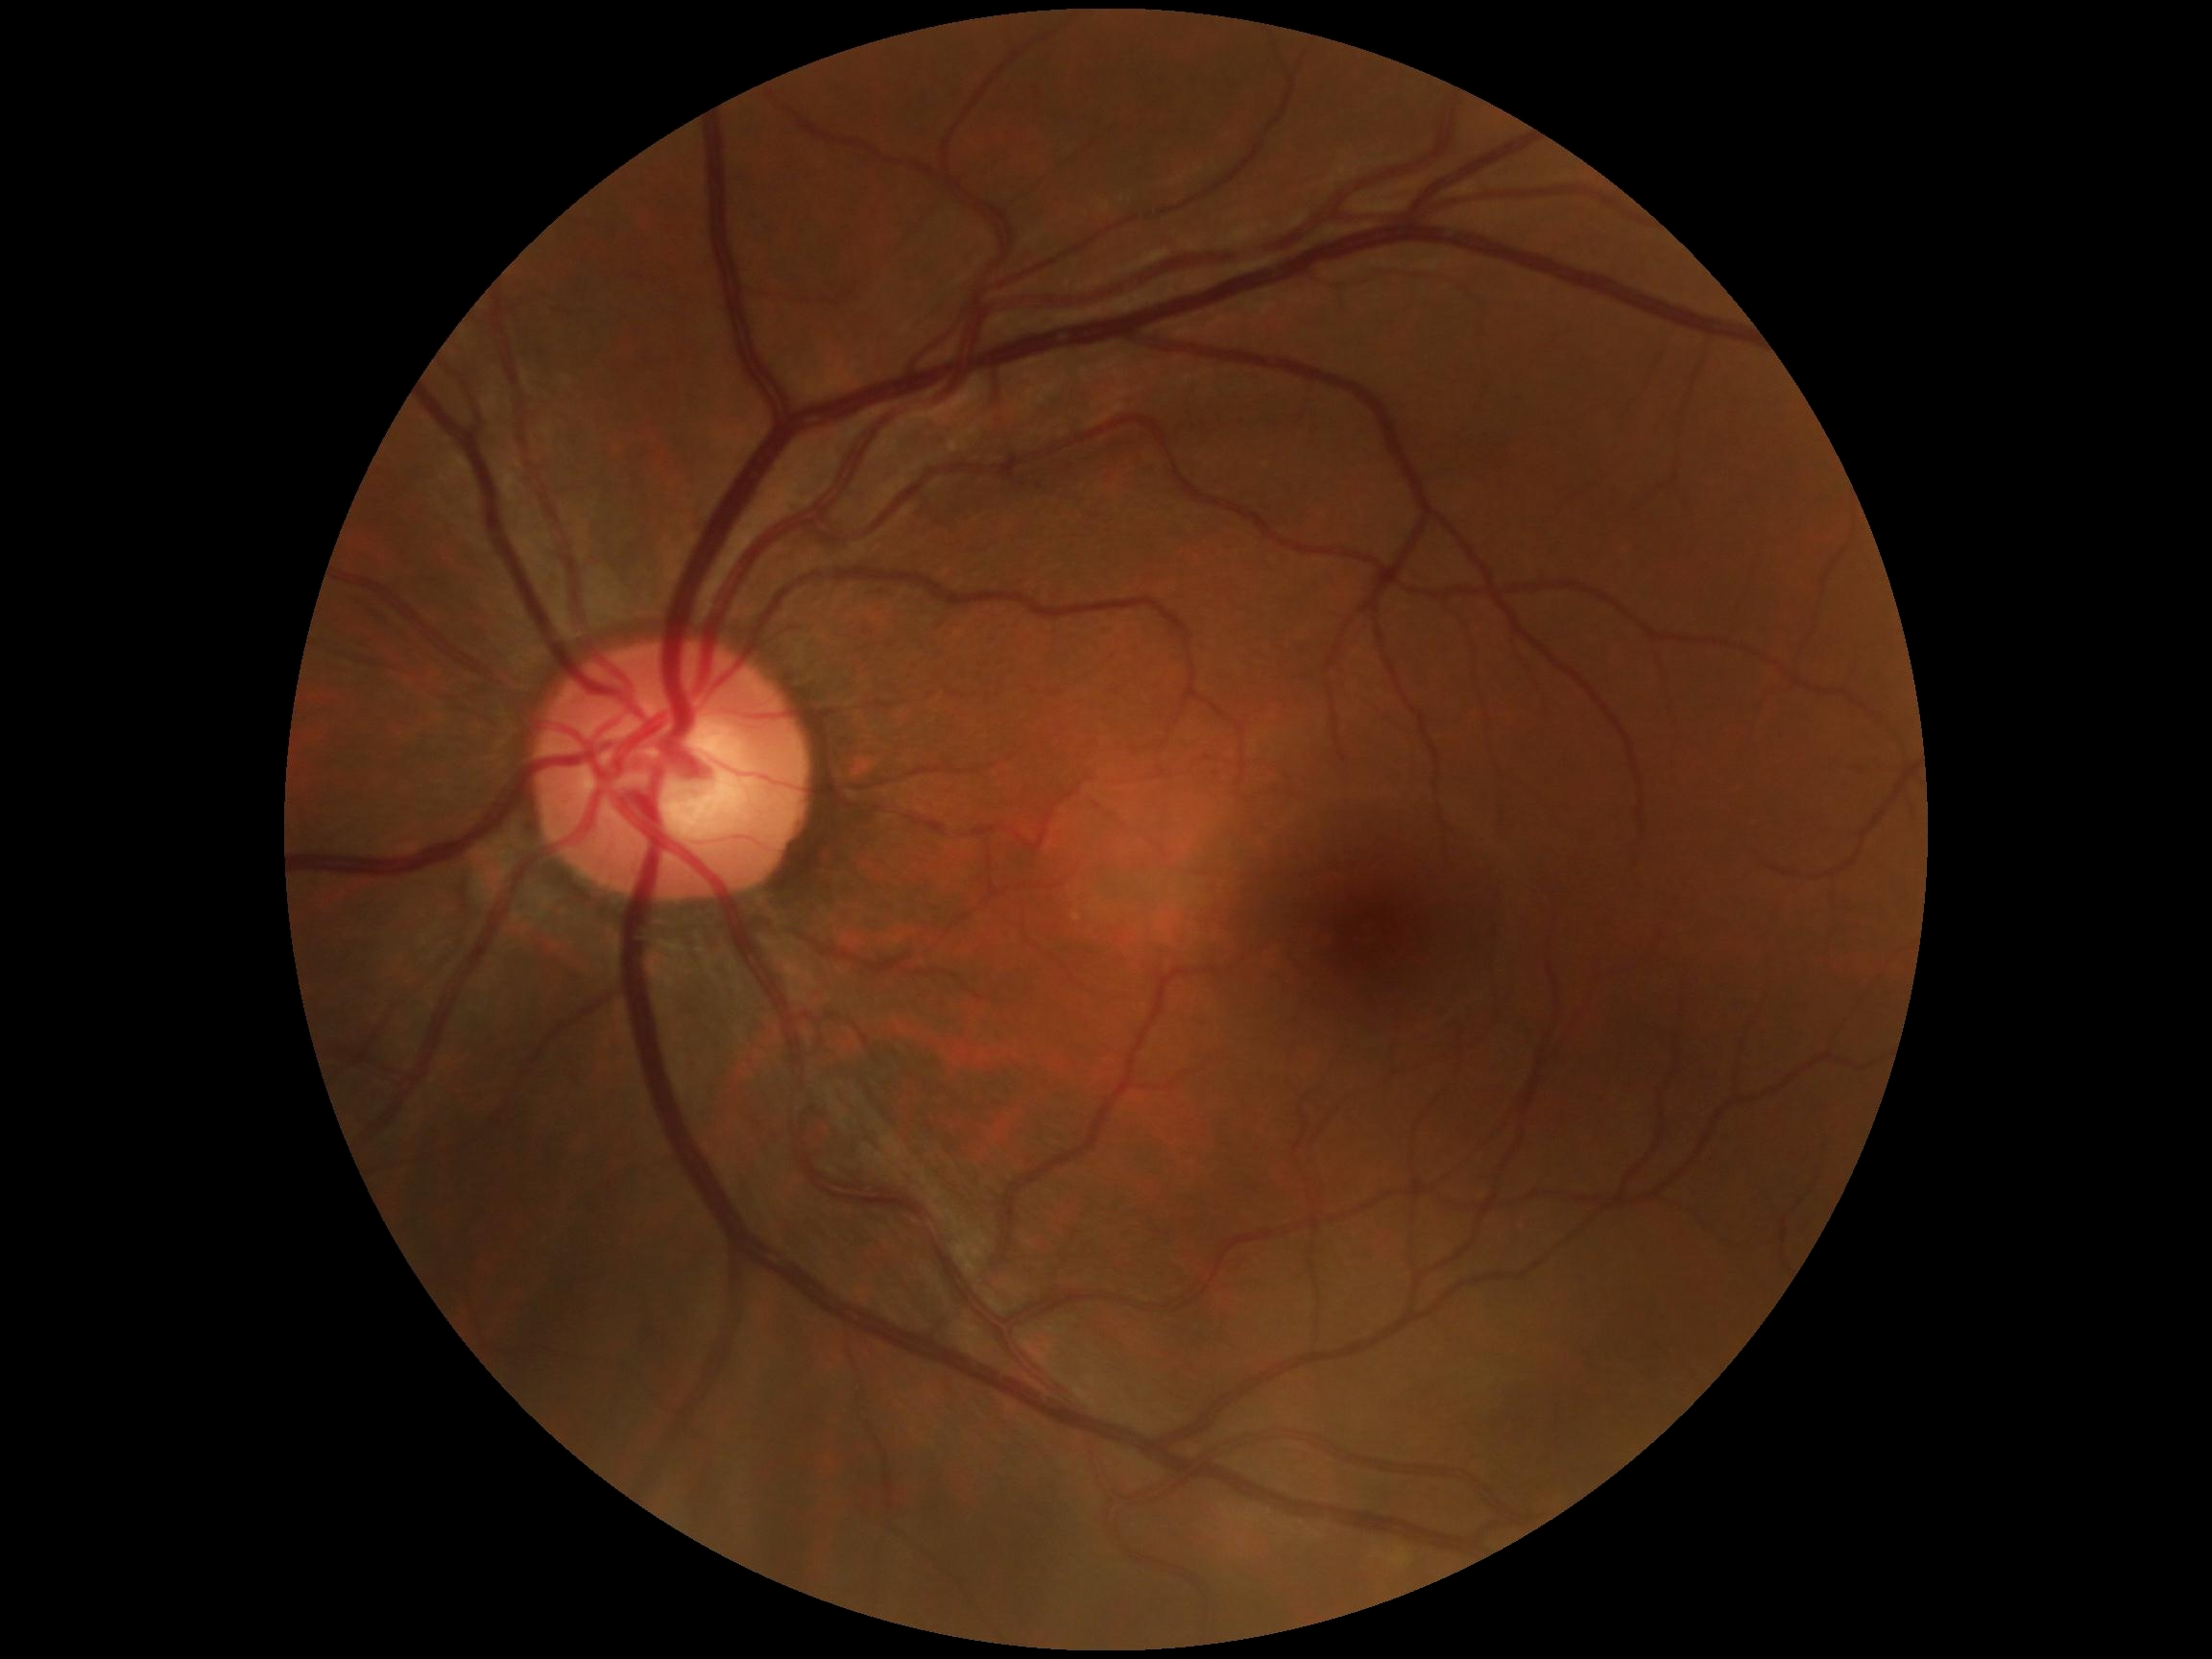 No diabetic retinal disease findings. Diabetic retinopathy (DR): grade 0.